45° FOV, color fundus photograph:
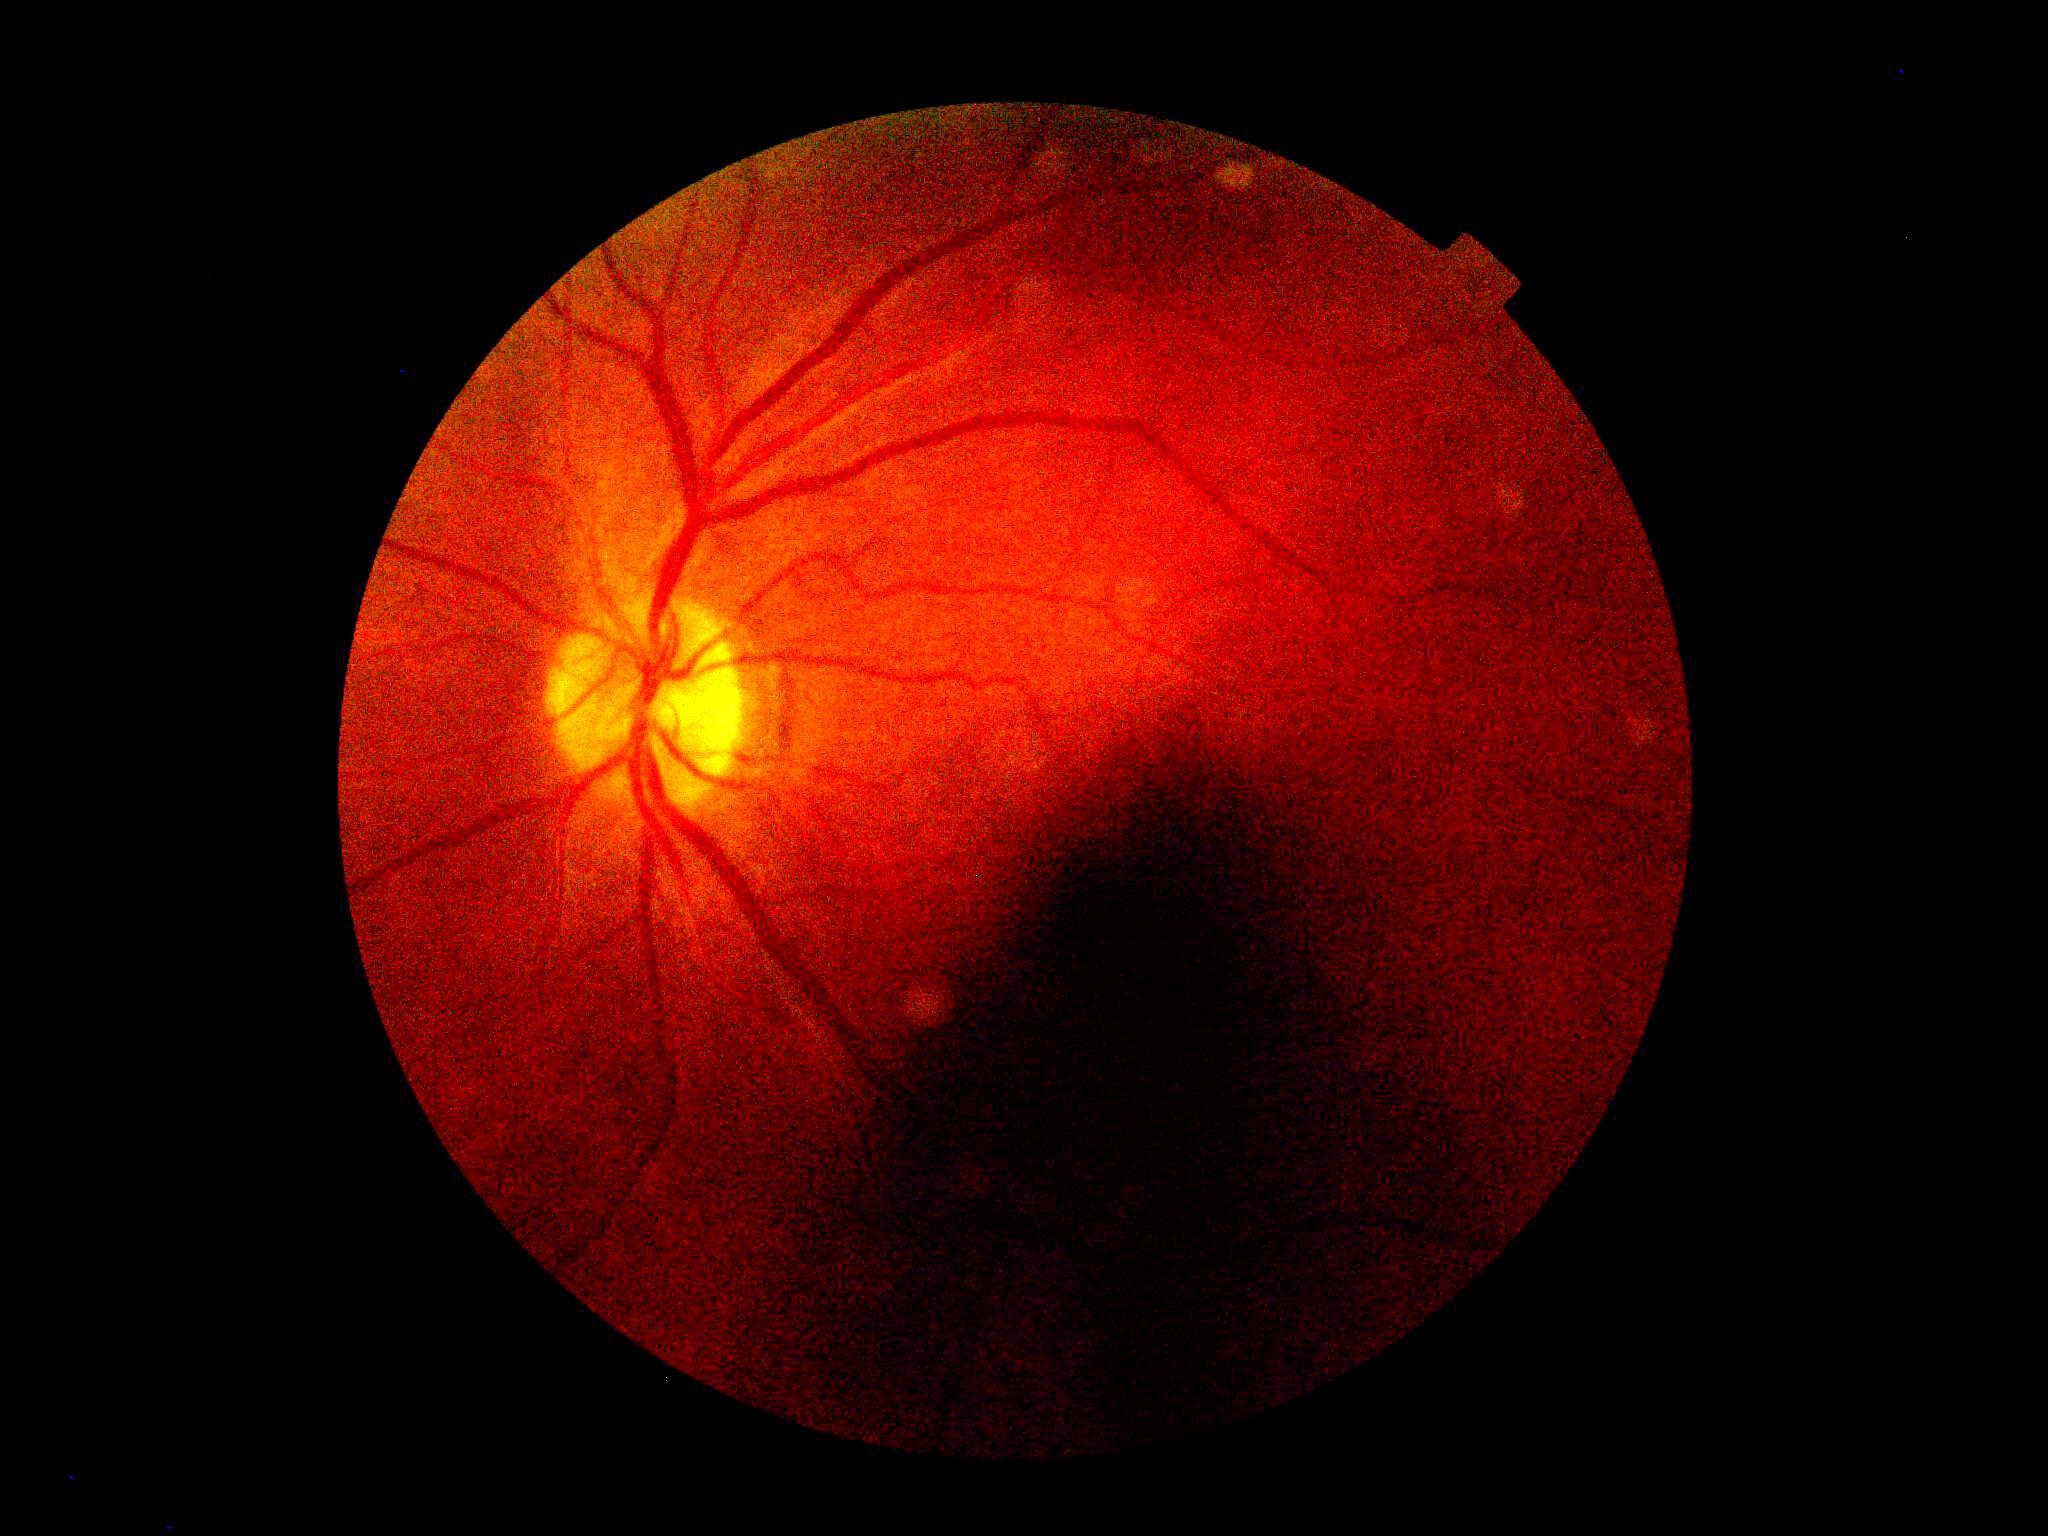 DR: ungradable. Quality too poor to assess for DR.